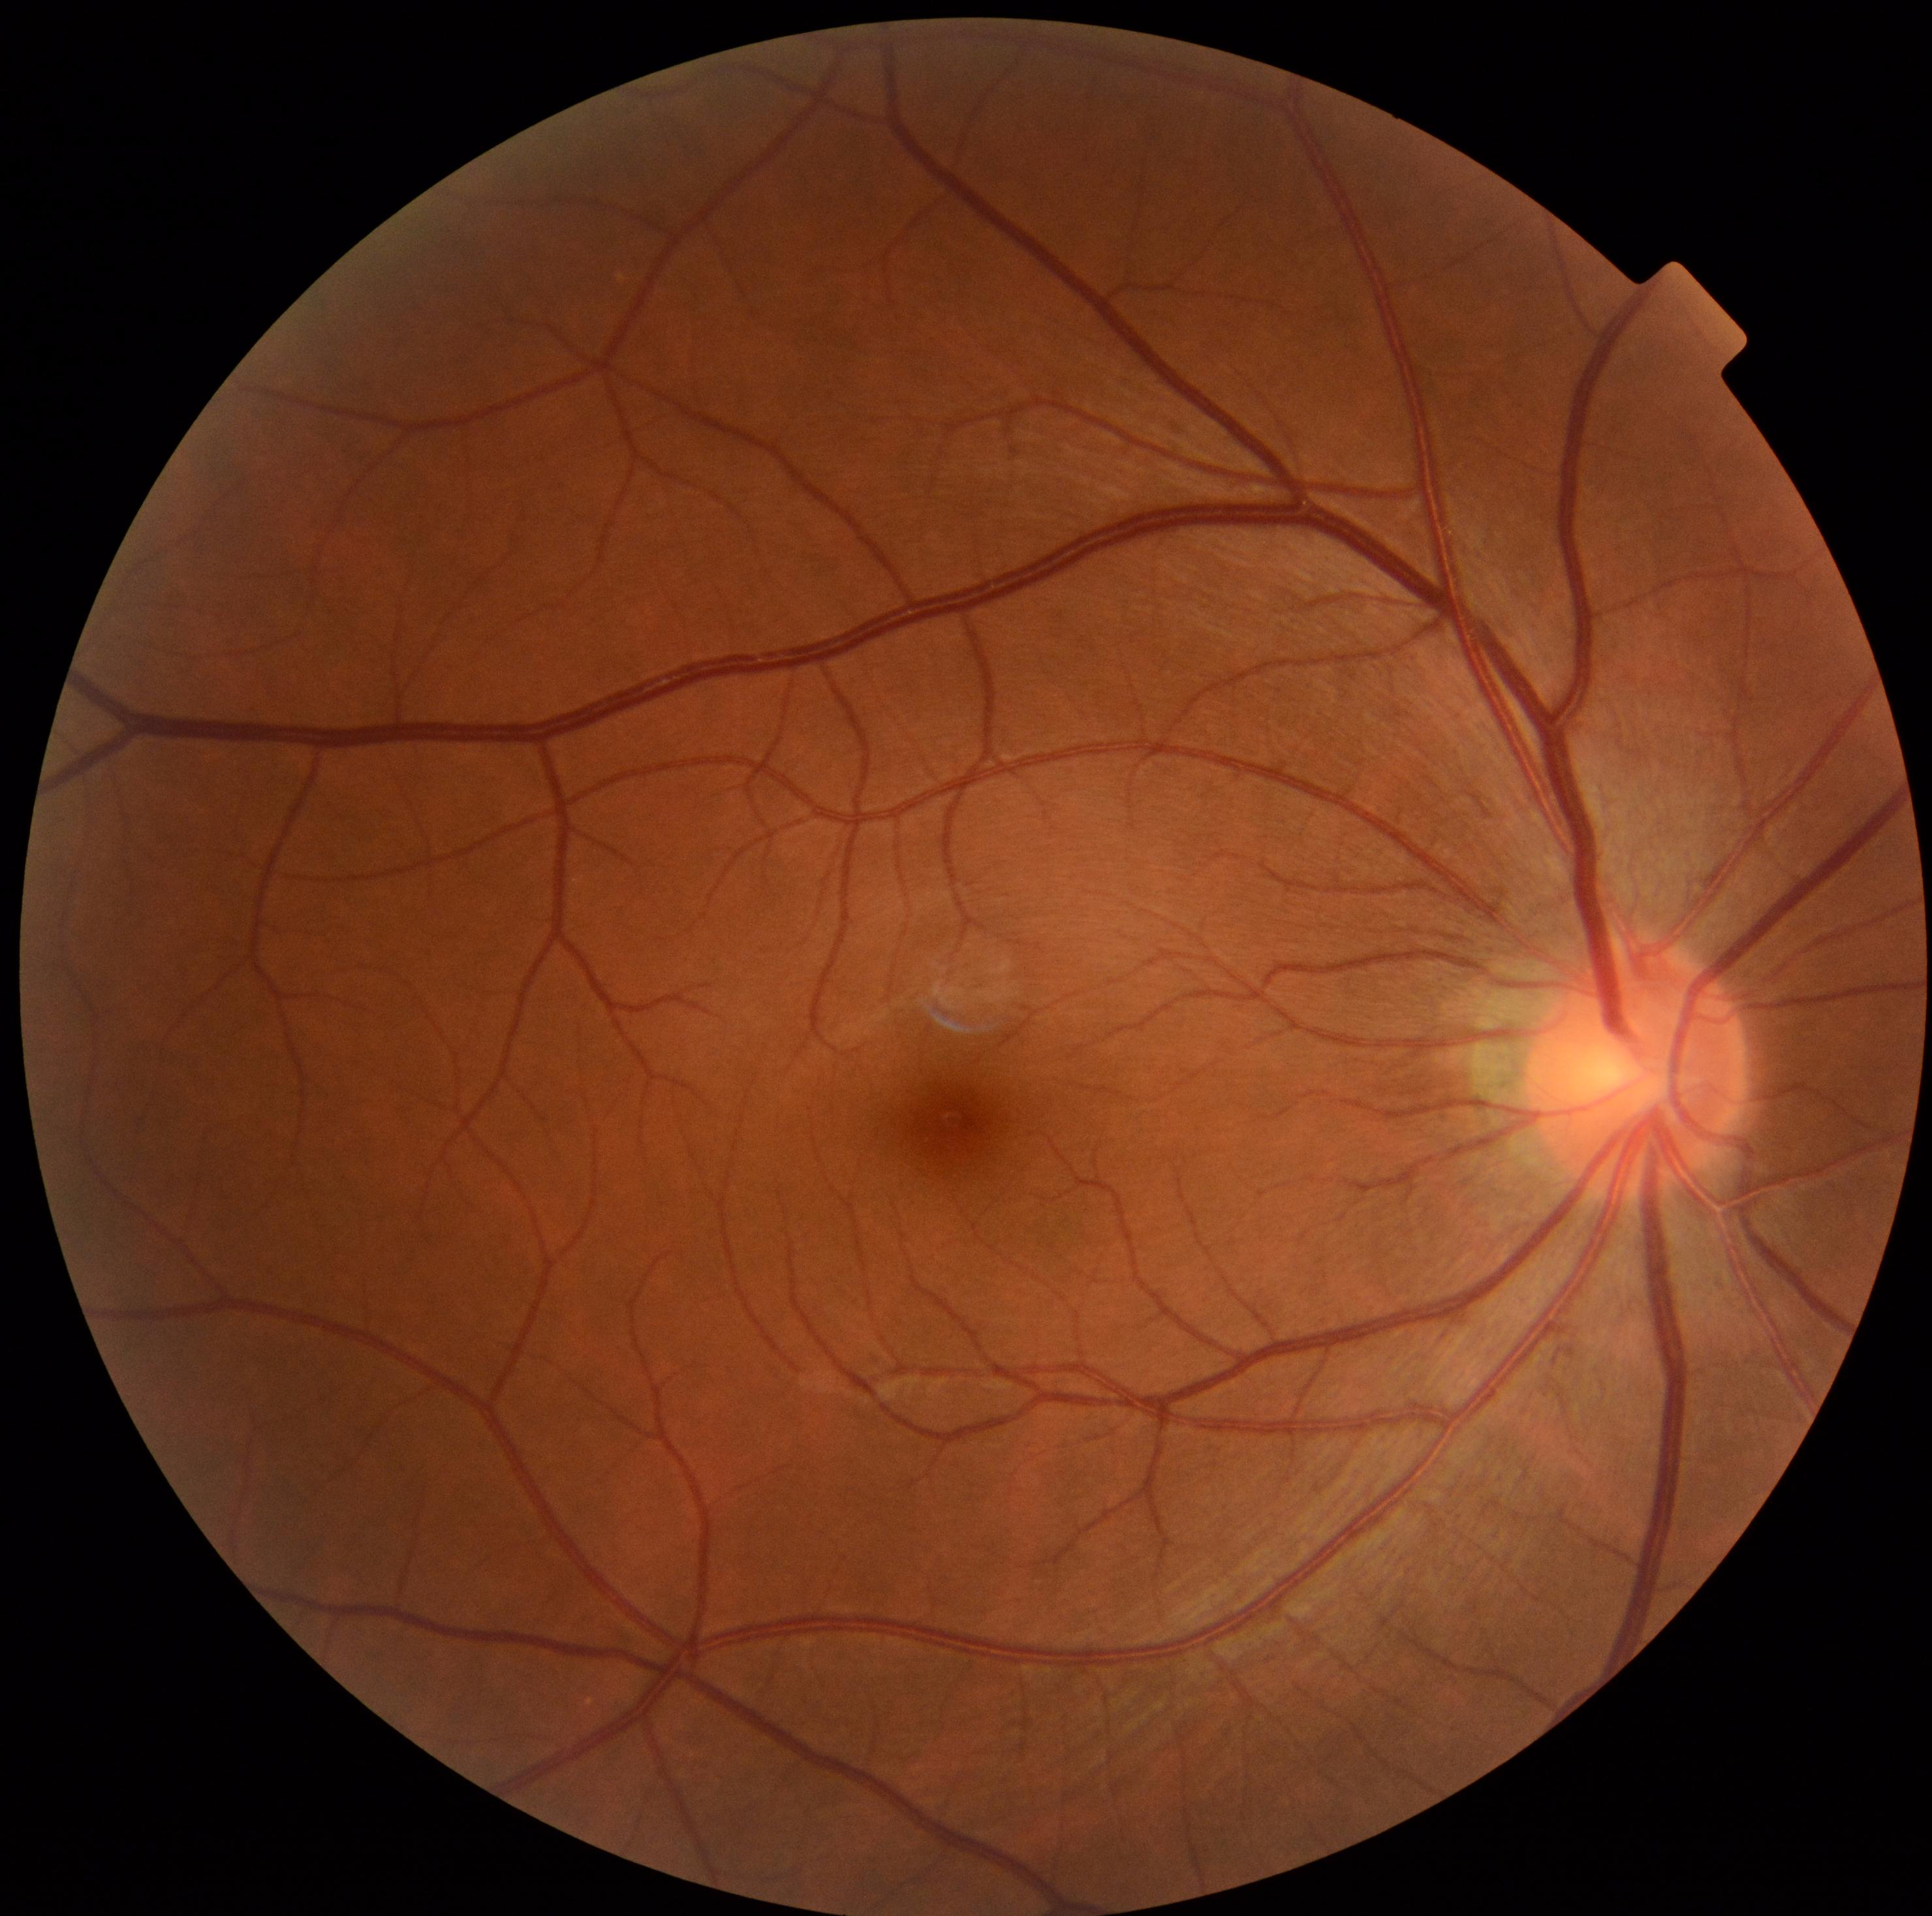
diabetic retinopathy severity=0/4 — no visible signs of diabetic retinopathy.